2089 x 1764 pixels: 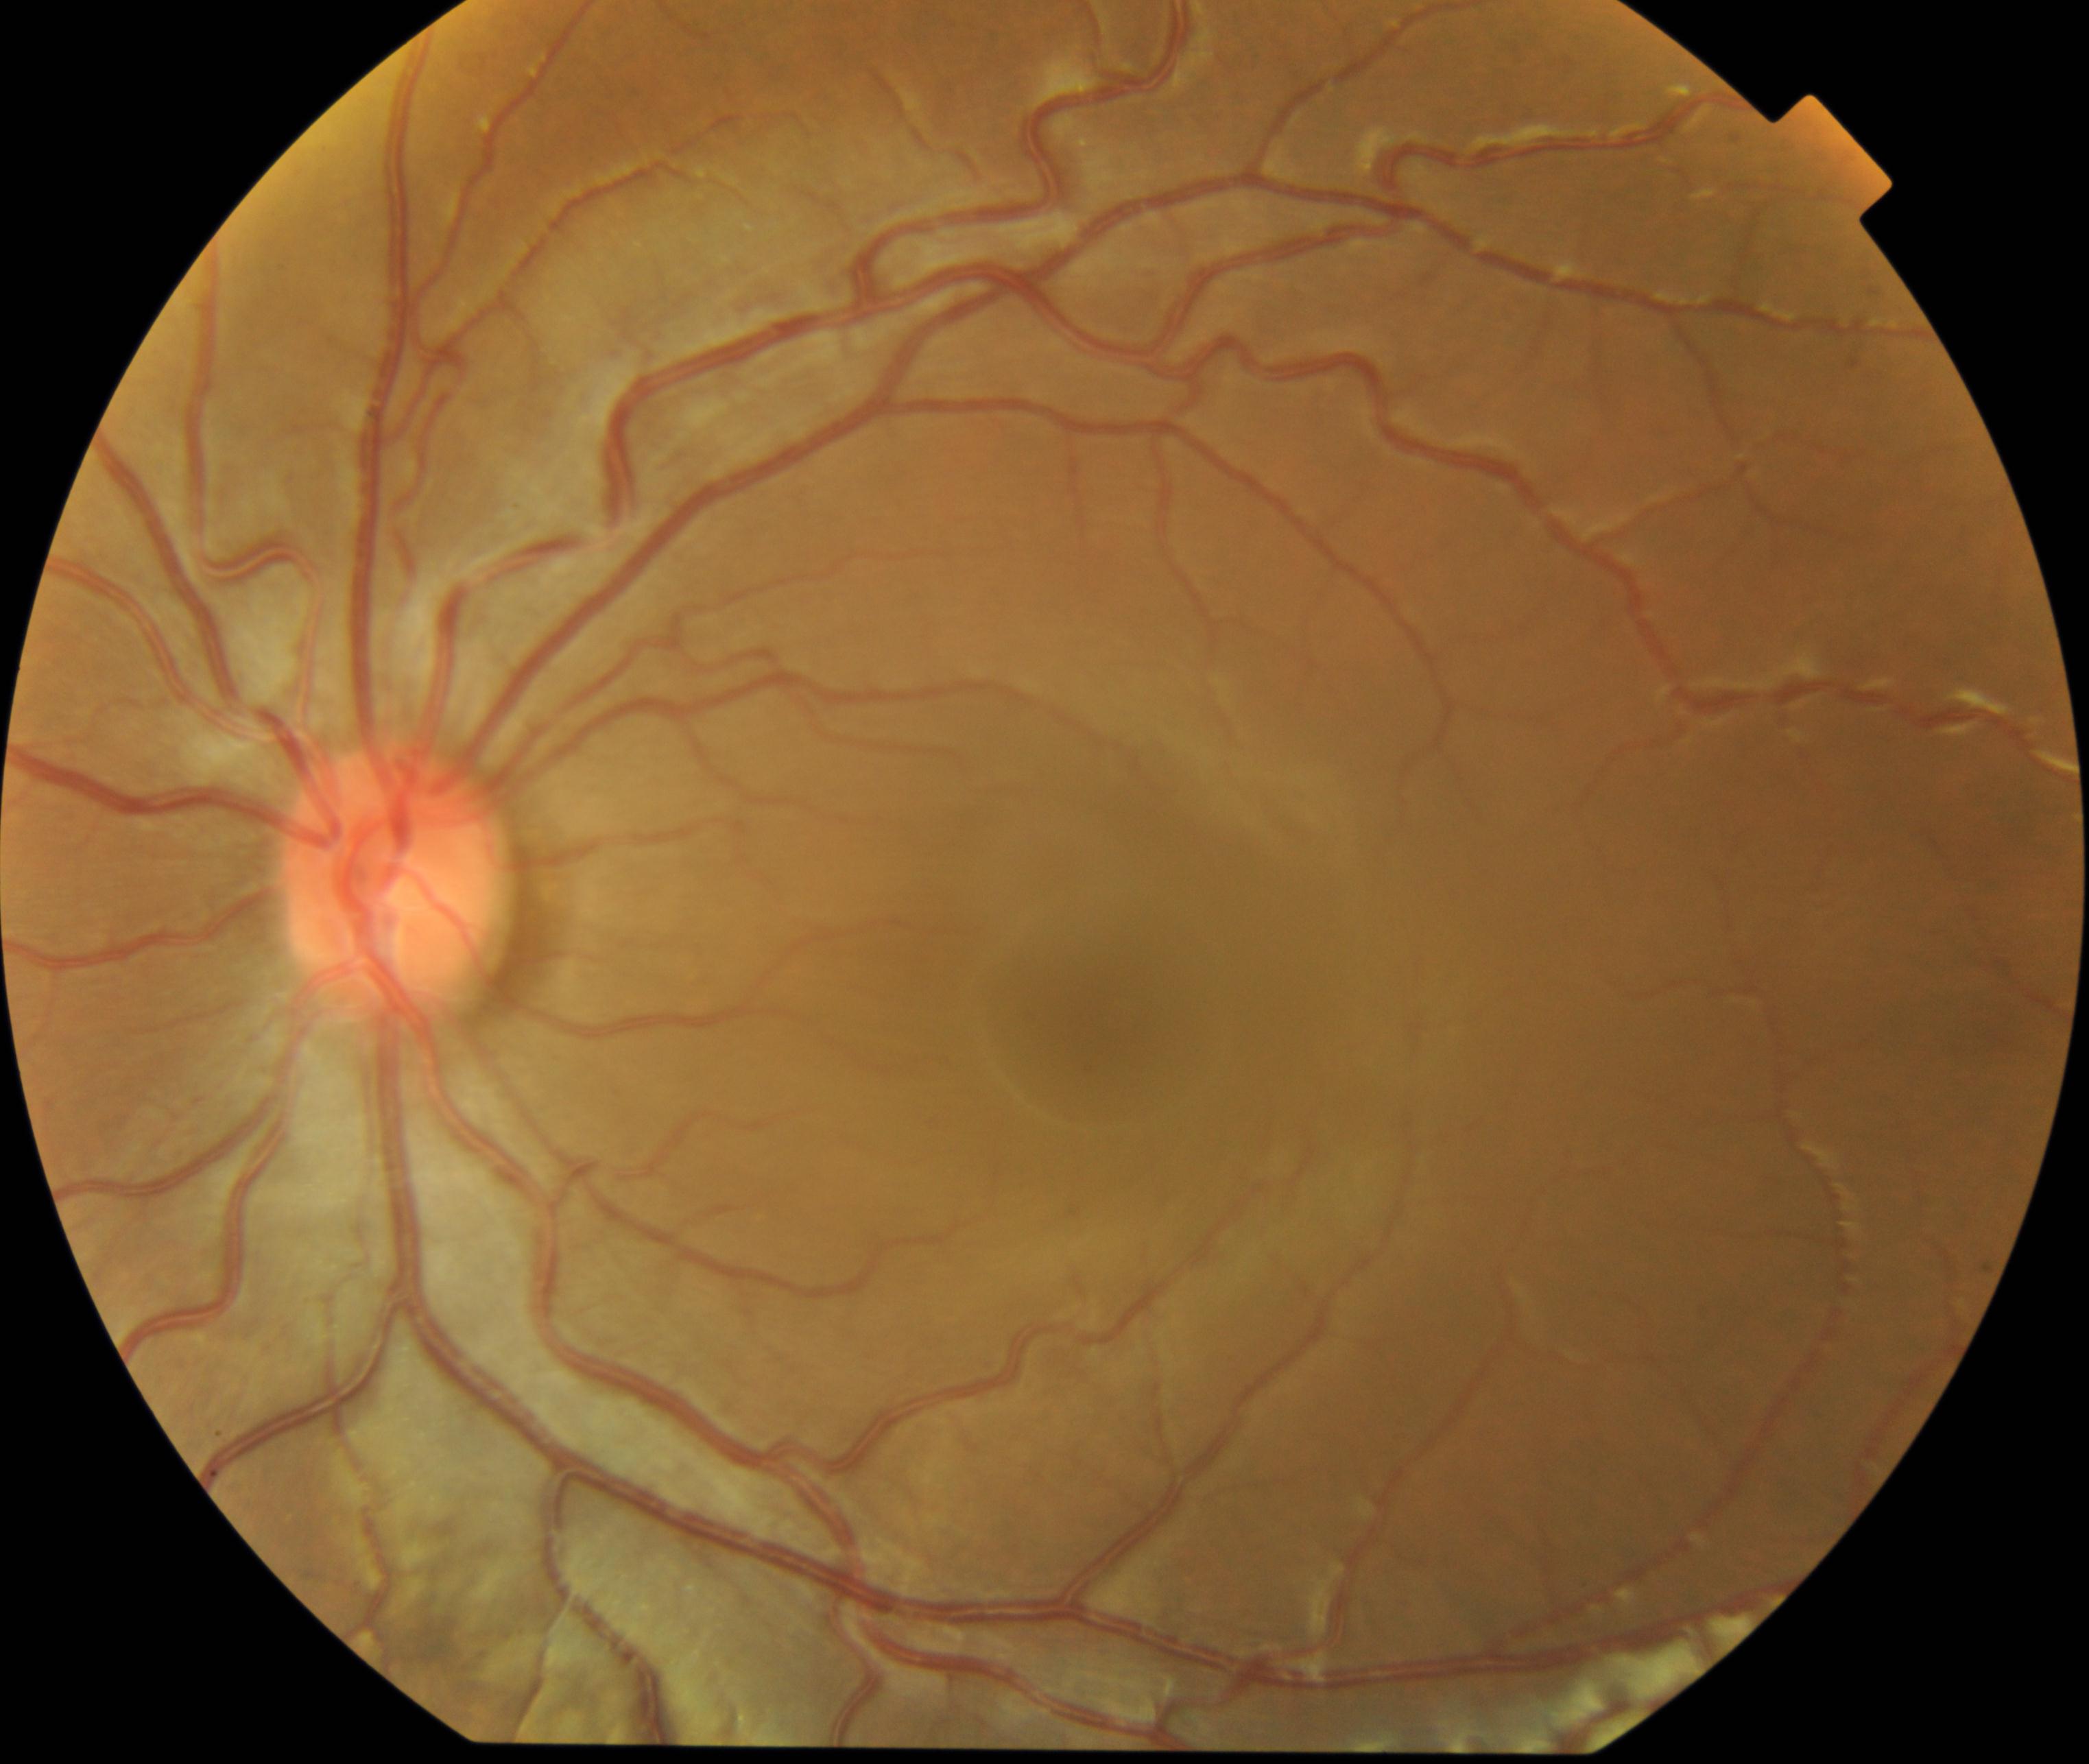 Impression: vessel tortuosity.